45-degree field of view. 848 by 848 pixels. Fundus photo. NIDEK AFC-230: 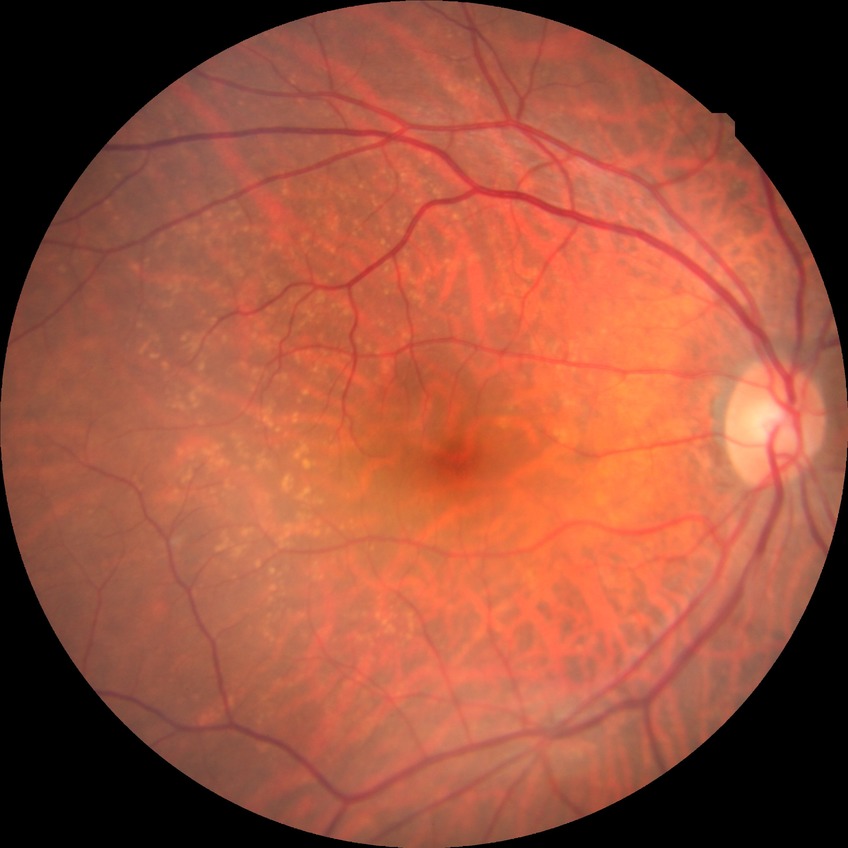

Diabetic retinopathy (DR): NDR (no diabetic retinopathy).